Retinal fundus photograph: 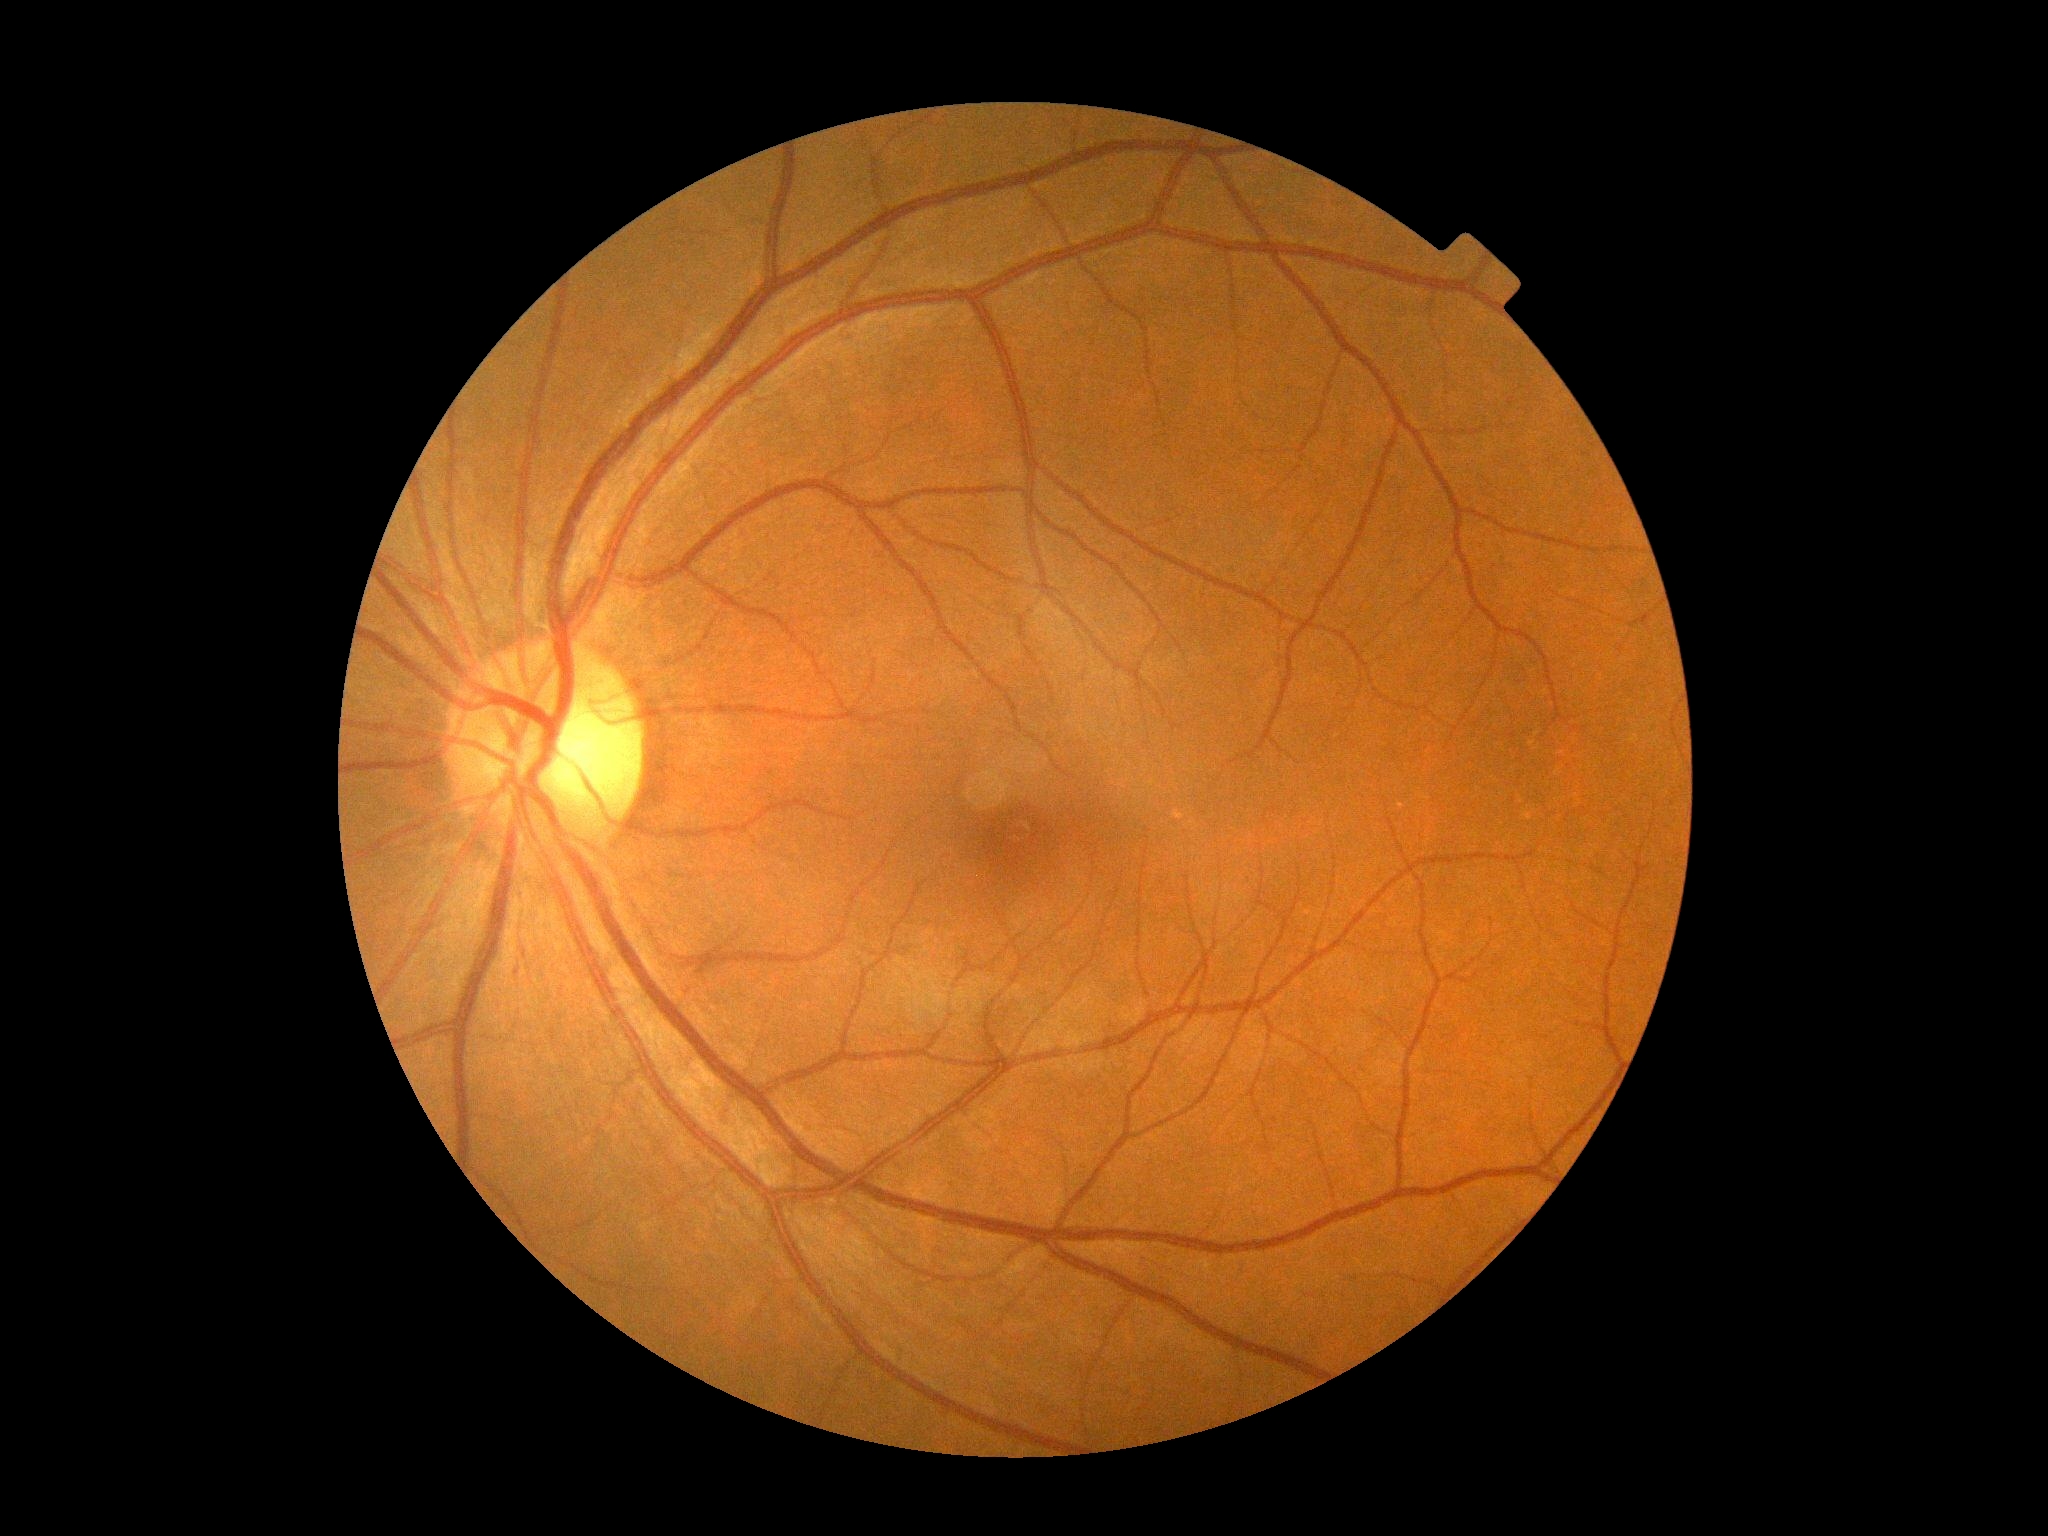 Retinopathy grade is 0. No signs of diabetic retinopathy.